45° FOV; color fundus photograph:
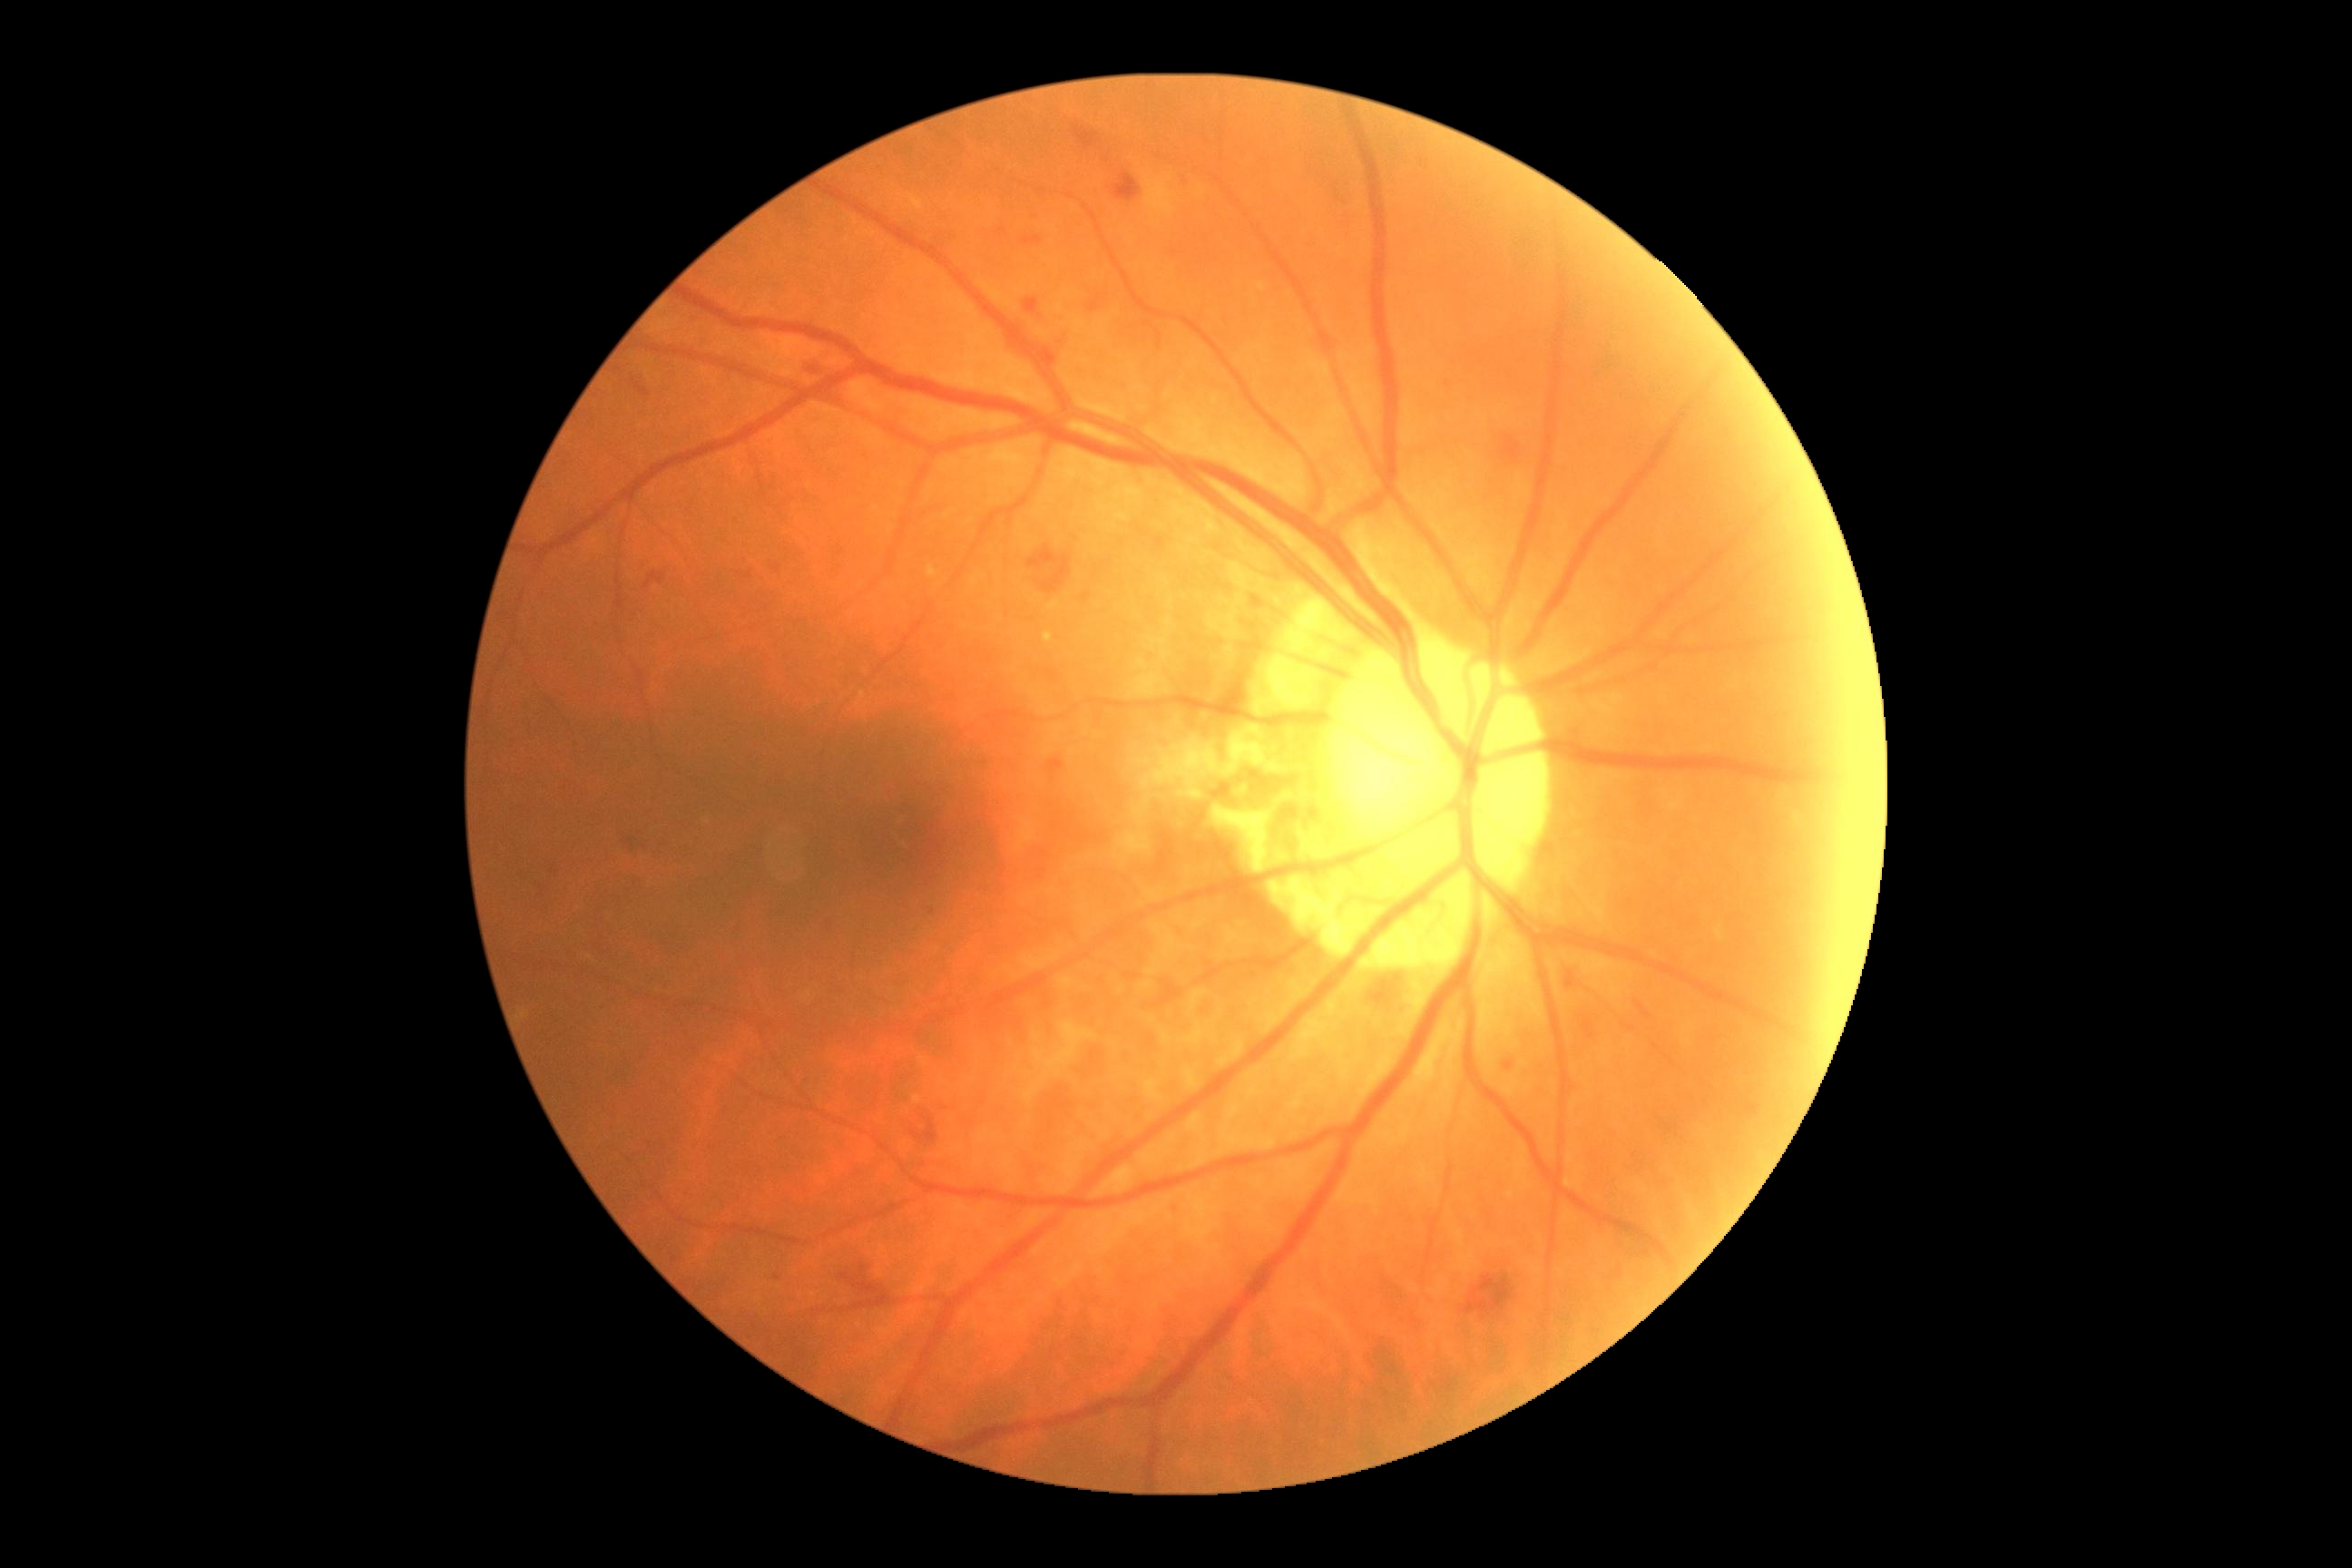 {"partial":true,"dr_grade":2,"dr_grade_name":"moderate NPDR","lesions":{"he":[[1017,1148,1059,1195],[525,872,562,901],[1075,126,1099,148],[645,573,665,589],[1504,1061,1514,1072],[912,1115,939,1144],[1583,1023,1596,1039],[1164,1200,1182,1220],[1369,970,1420,1019],[1440,373,1456,404],[636,384,651,397],[1638,1004,1651,1019],[1084,594,1092,600],[1565,975,1576,988],[1006,297,1070,371]],"he_small_approx":[[777,568],[932,913]]}}